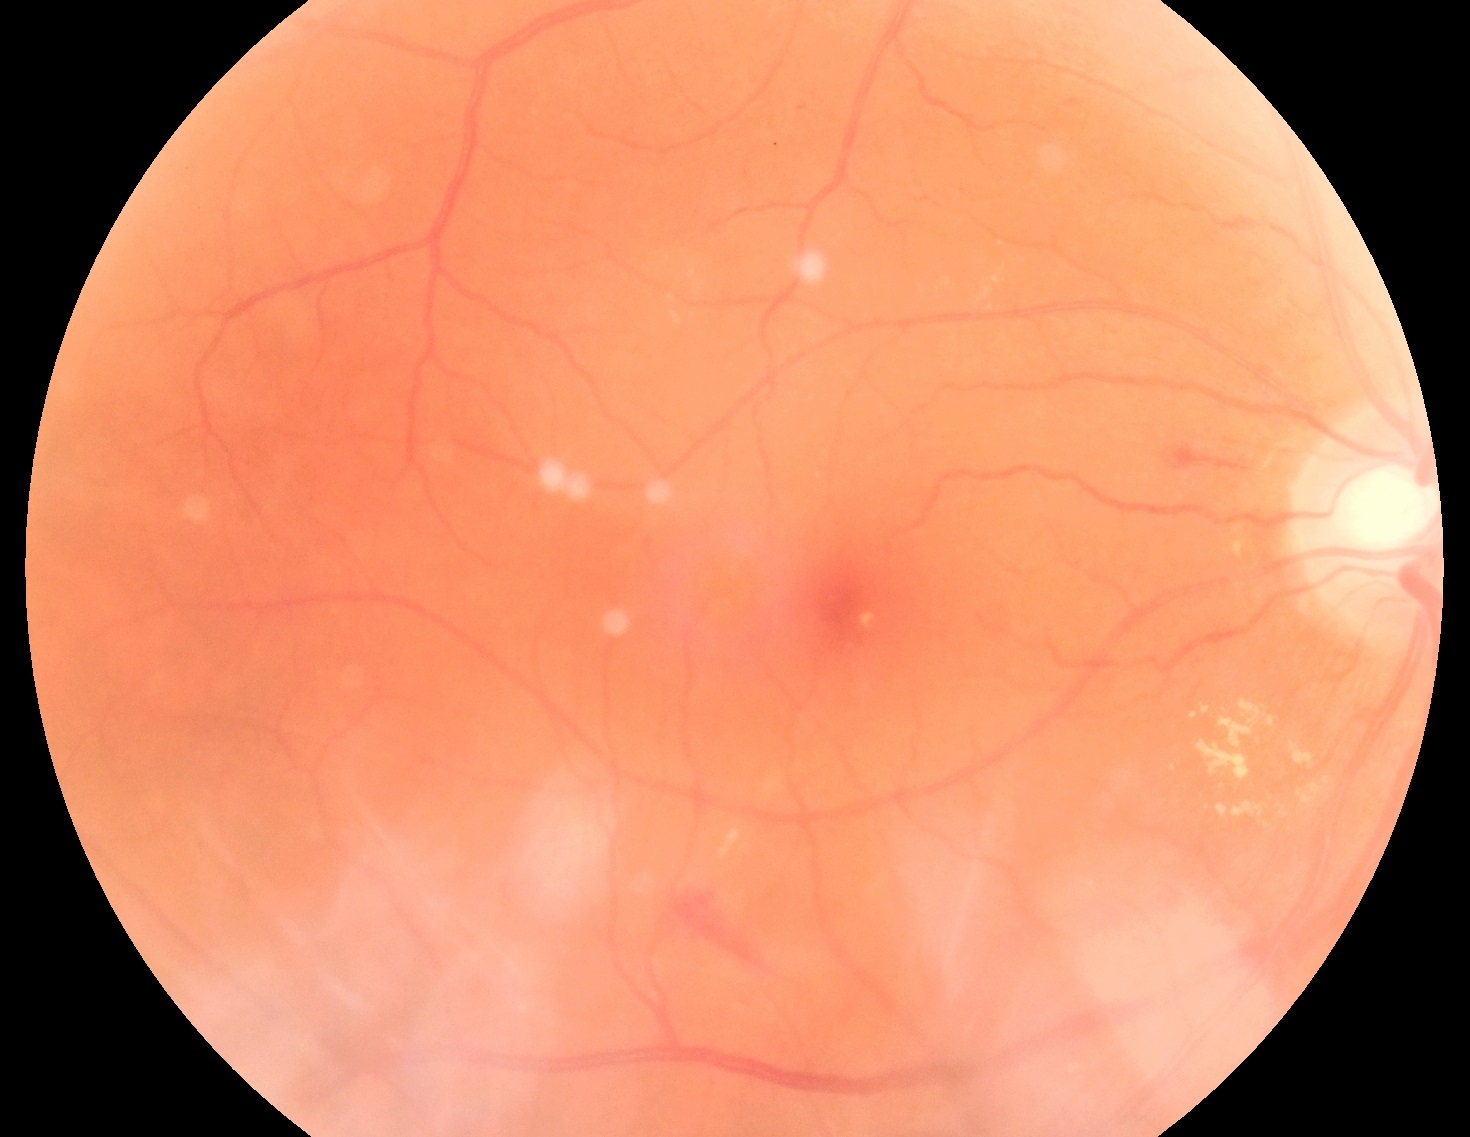
DR stage is grade 2 (moderate NPDR).